Nonmydriatic:
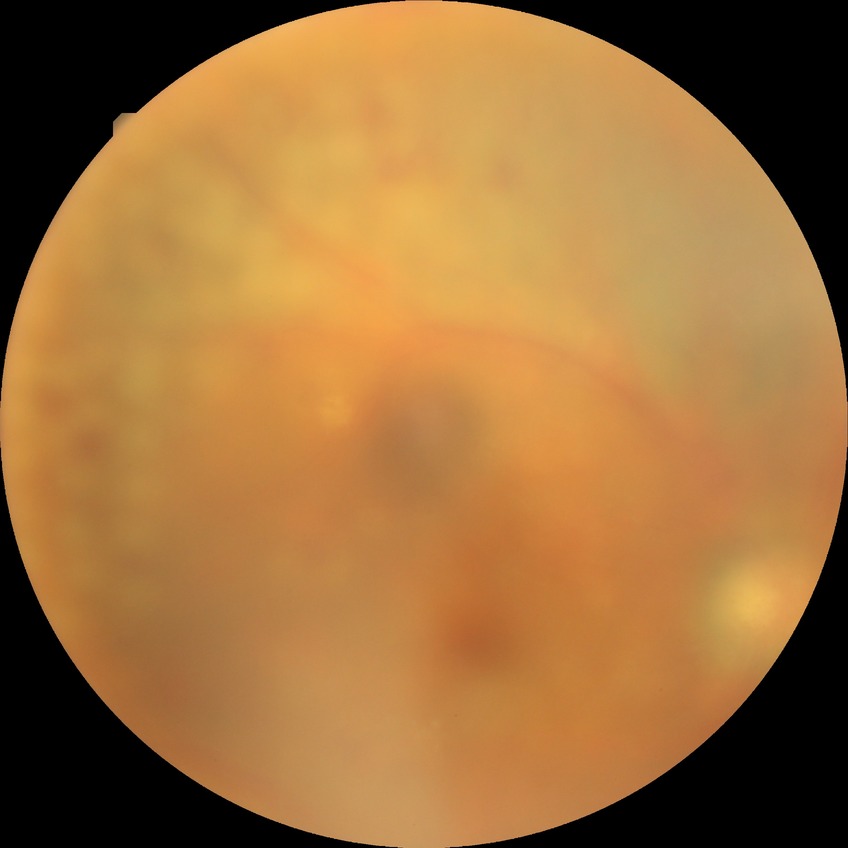
Retinopathy stage is proliferative diabetic retinopathy.